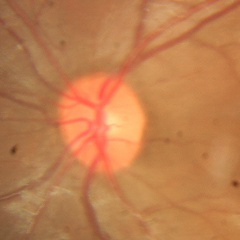

Optic disc appearance consistent with no glaucomatous changes.